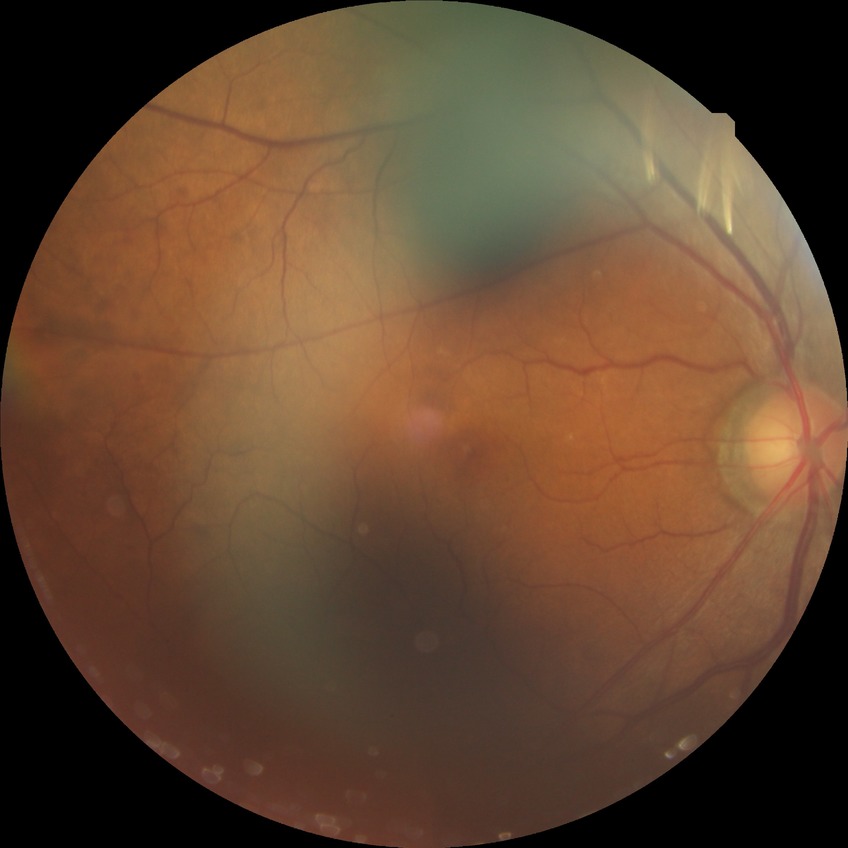

diabetic retinopathy stage: no diabetic retinopathy.